45-degree field of view — 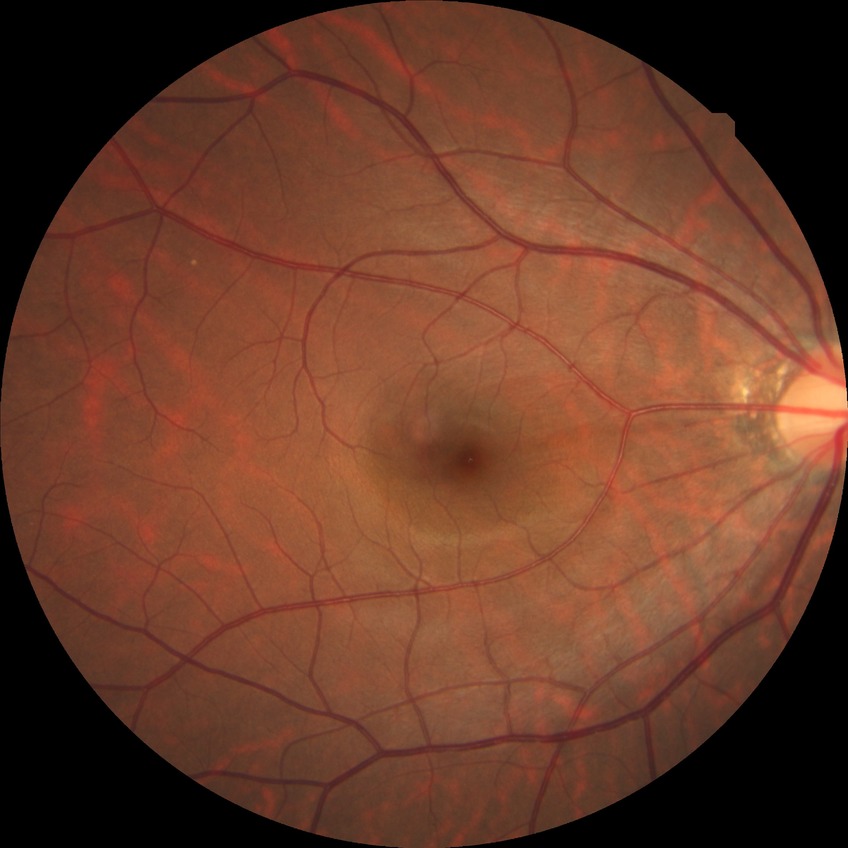
{"davis_grade": "no diabetic retinopathy"}